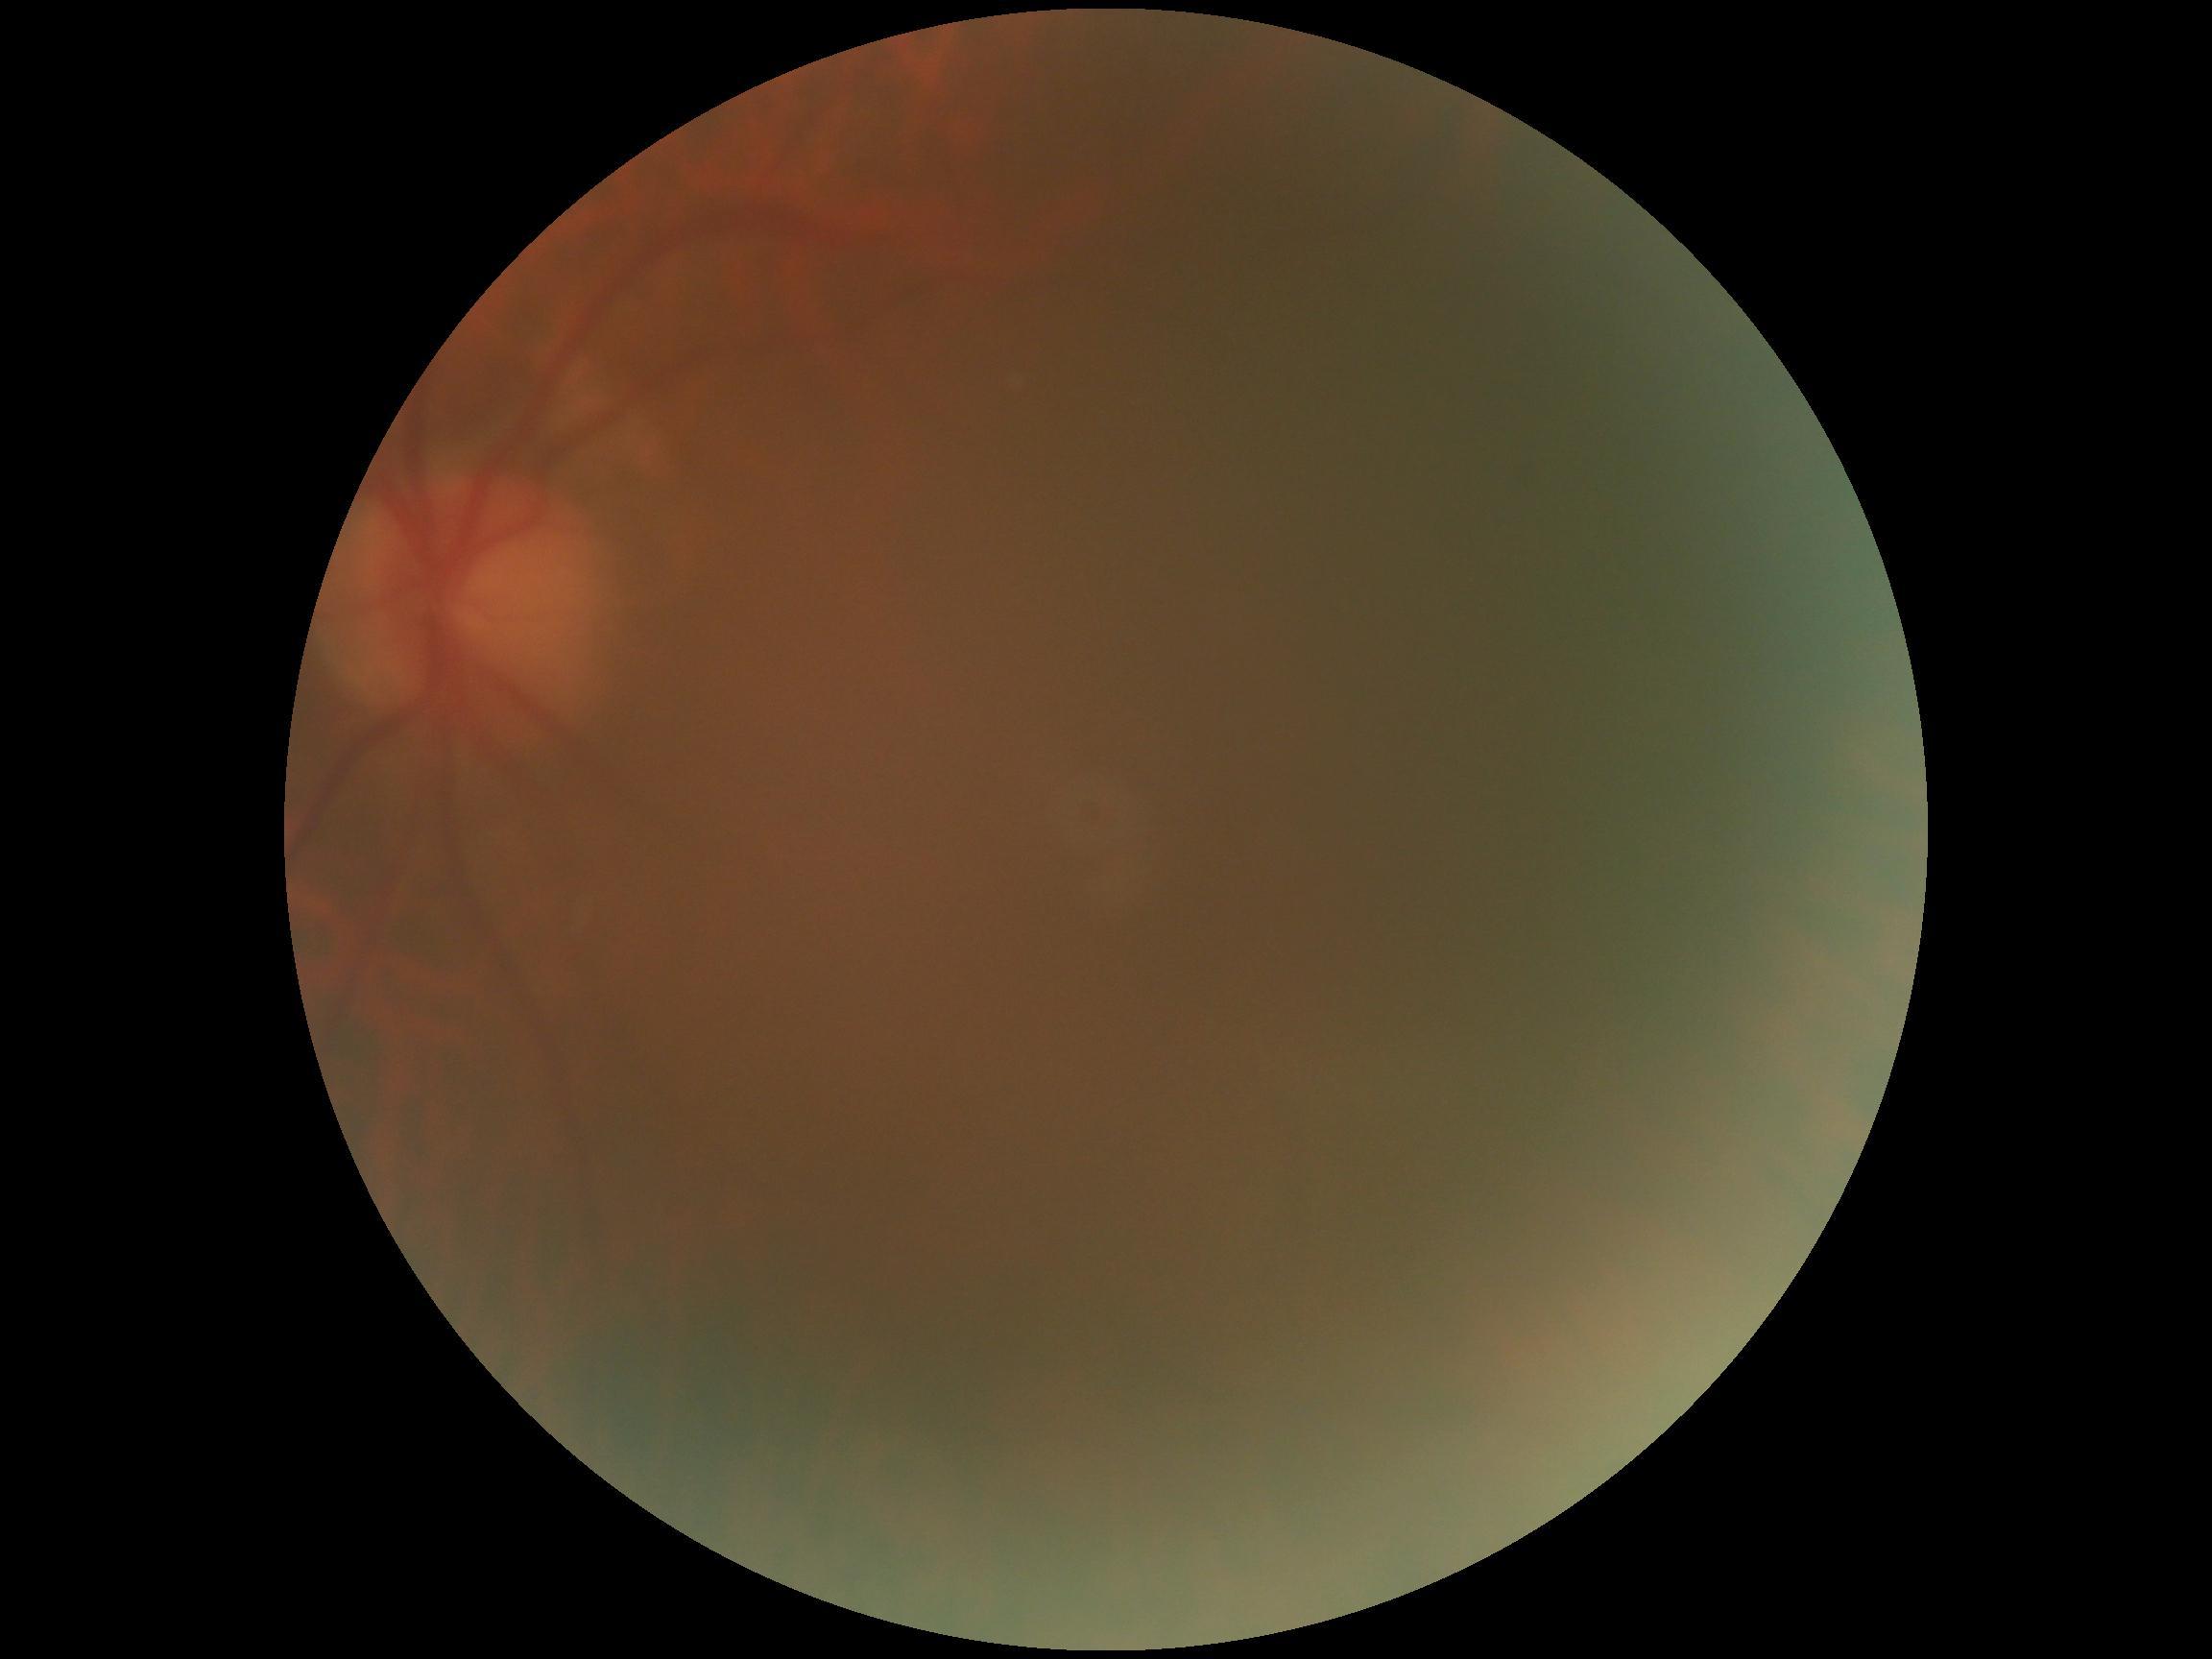

DR stage: ungradable.